Pediatric retinal photograph (wide-field); acquired on the Clarity RetCam 3:
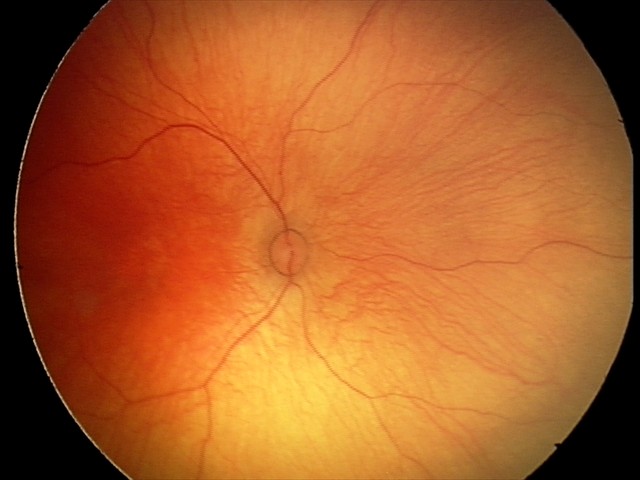 No retinal pathology identified on screening.